CFP
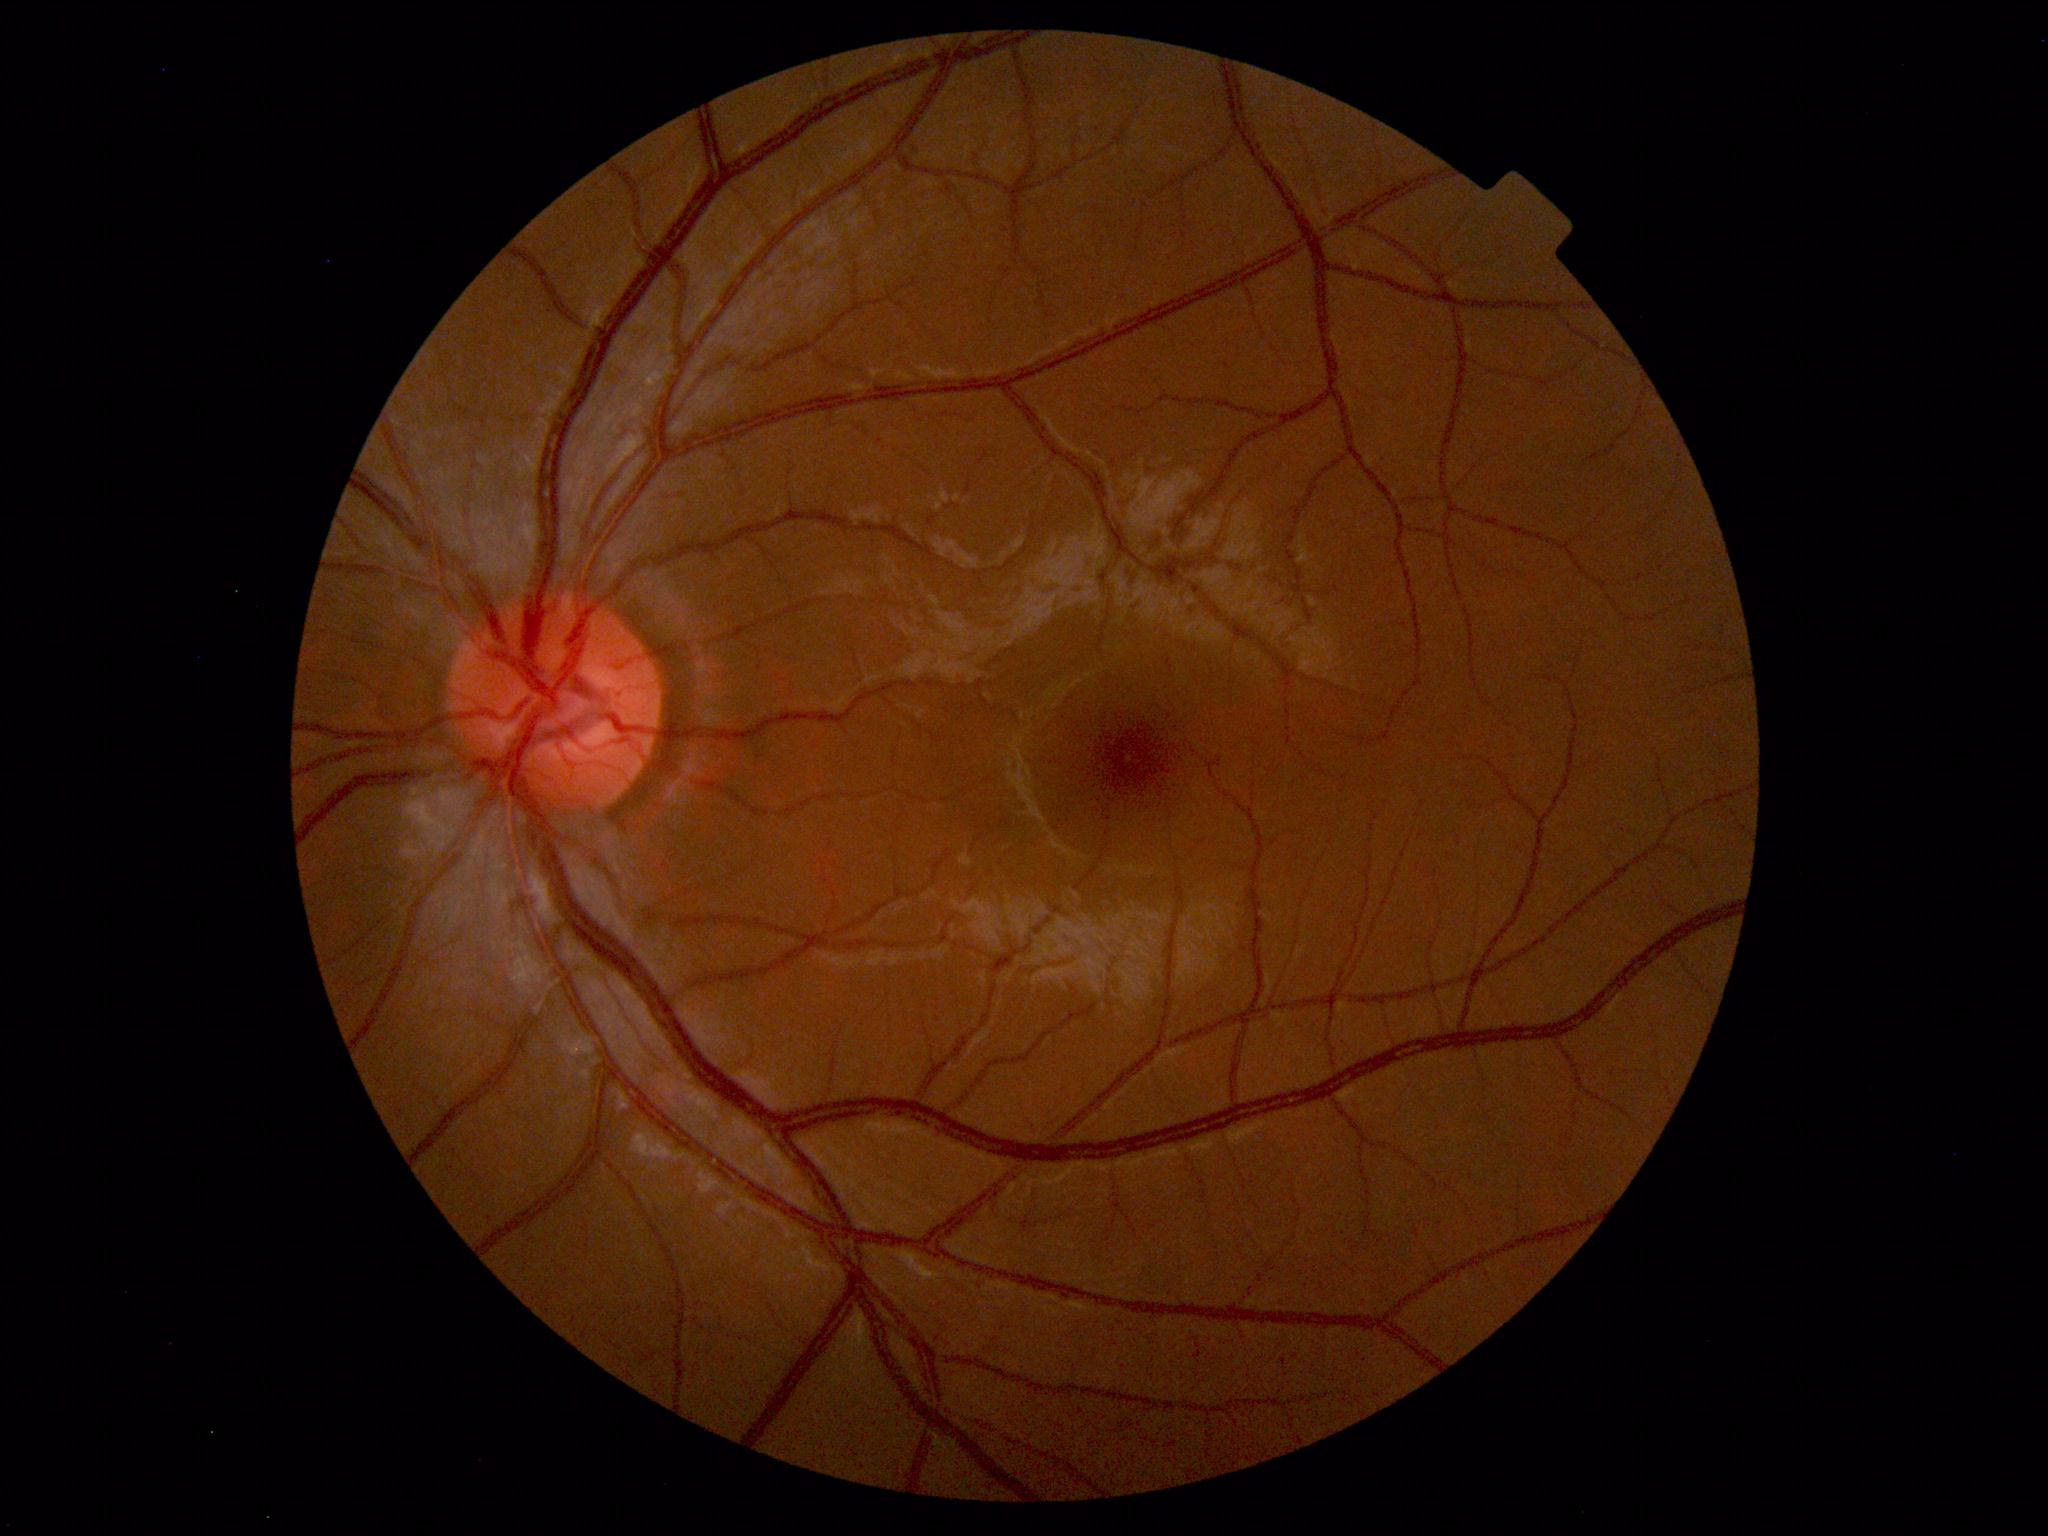

No abnormal findings on fundus examination.